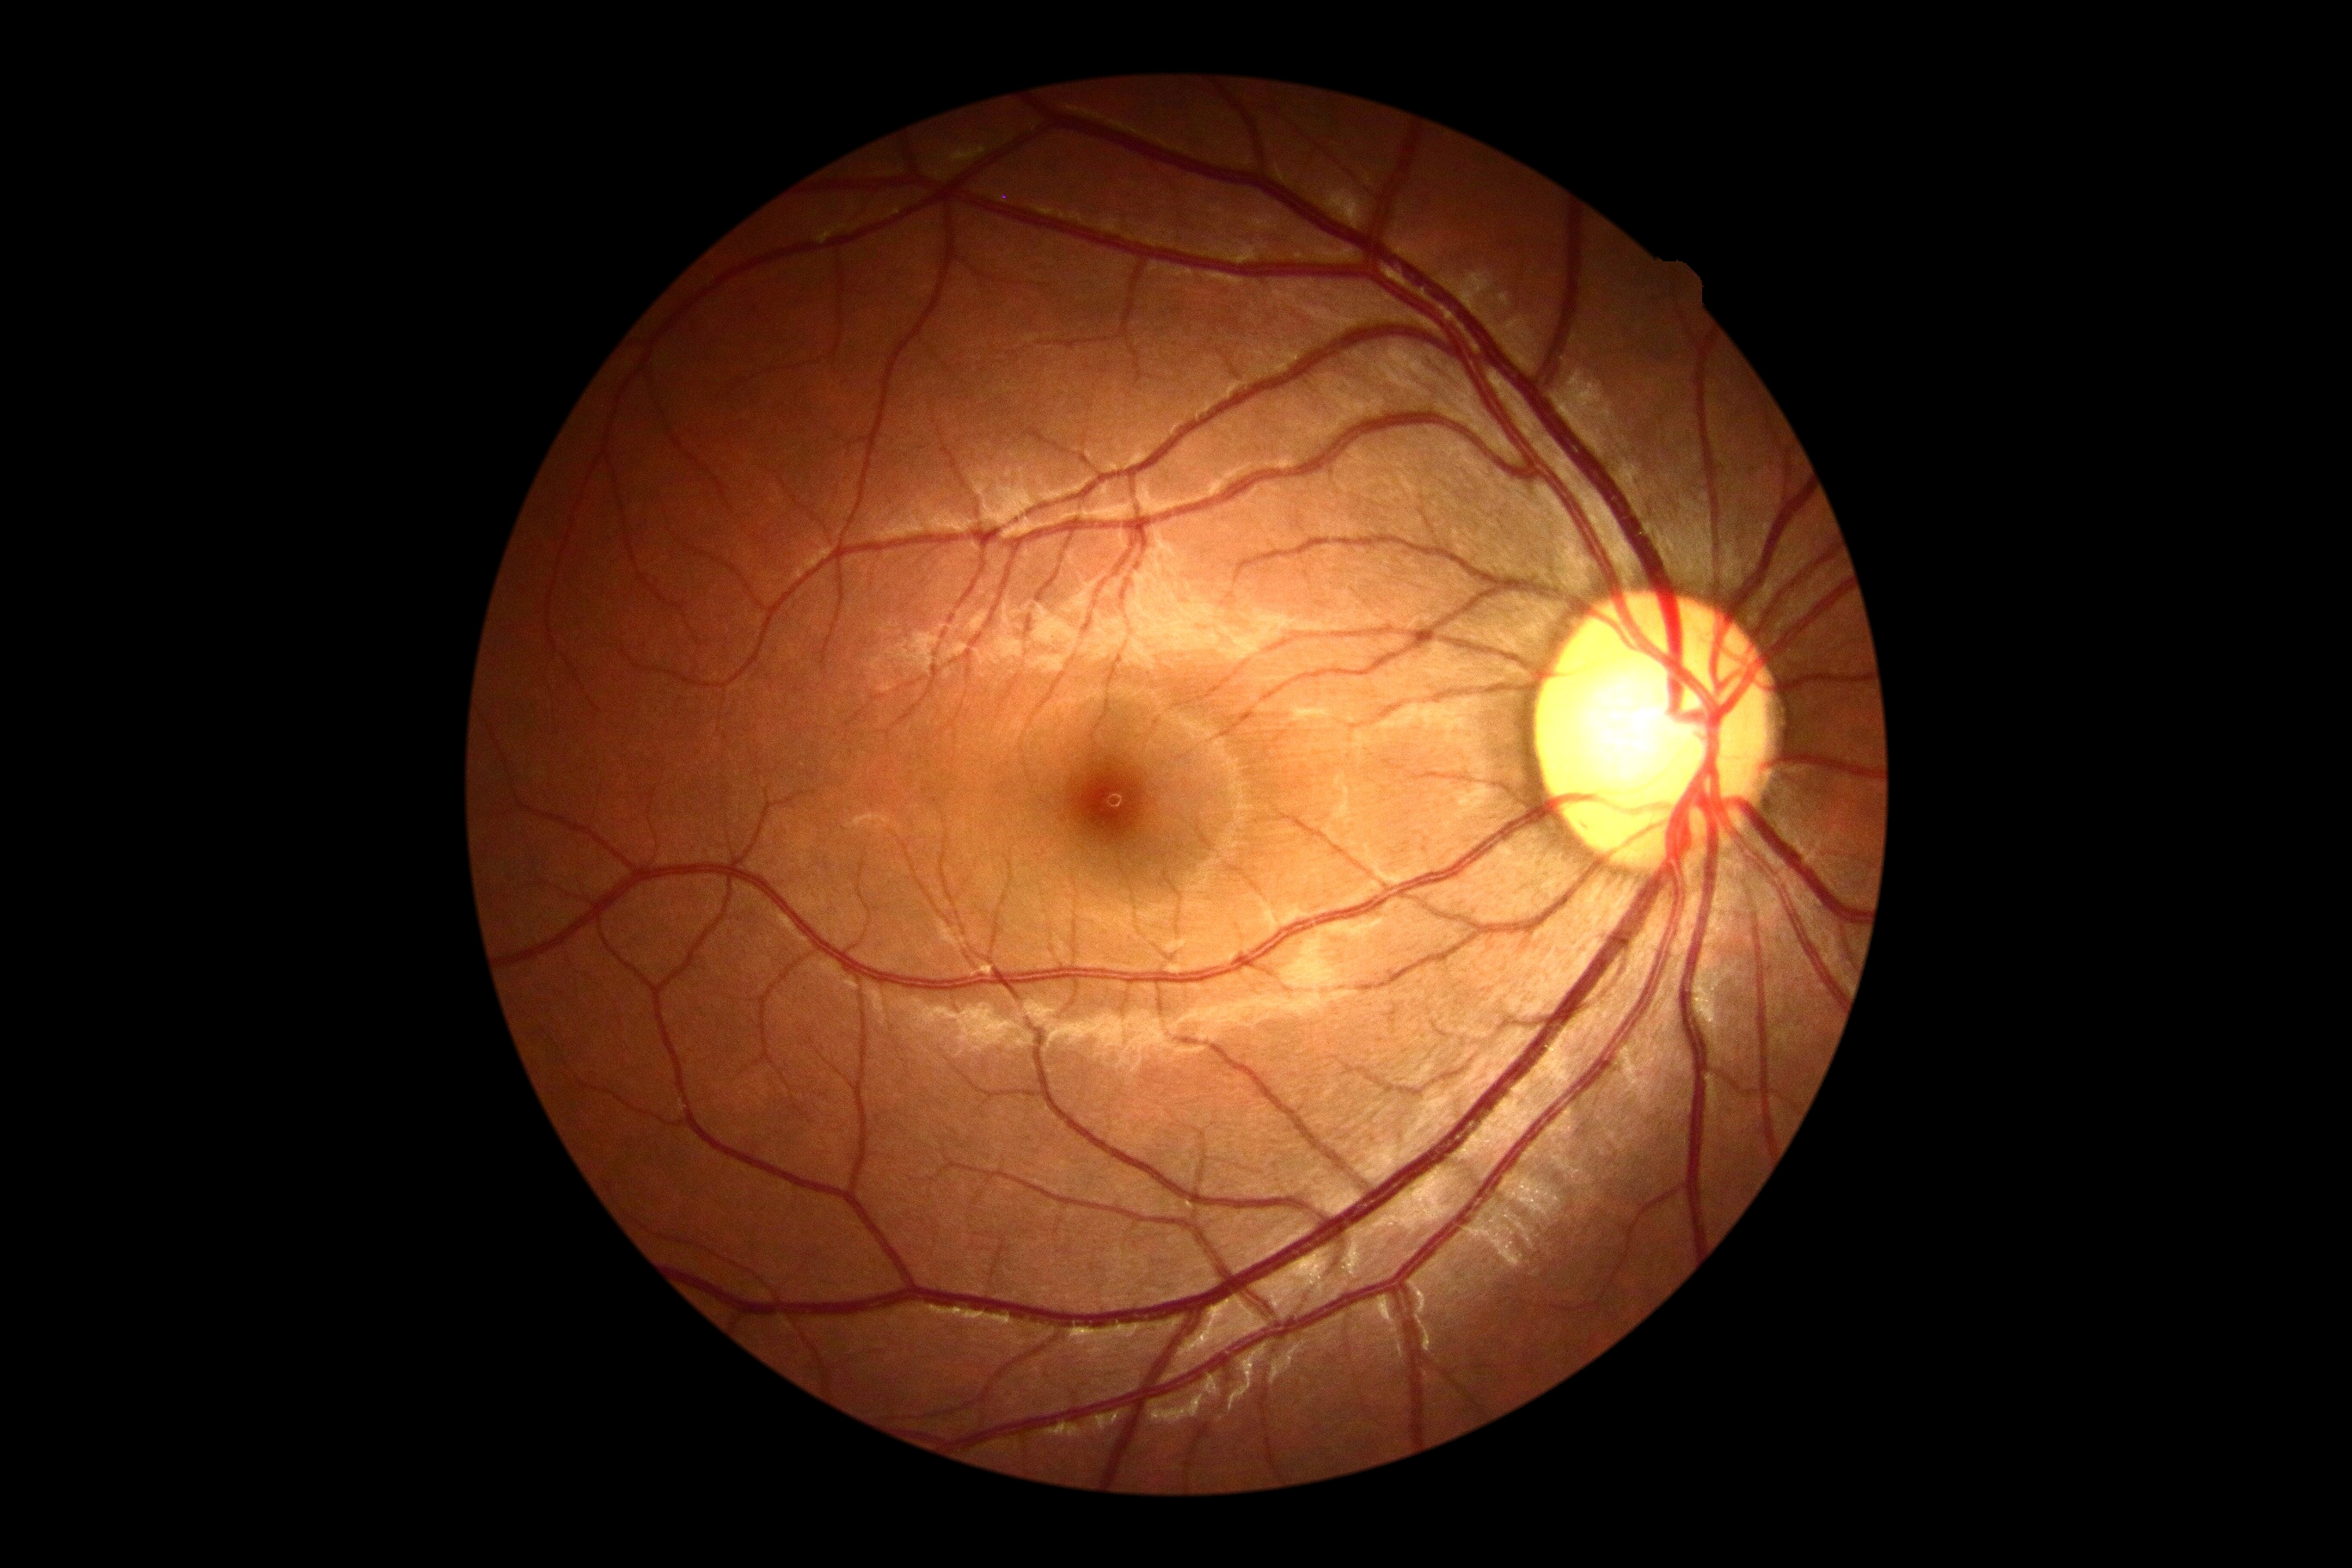

No DR findings.
Diabetic retinopathy grade is 0 (no apparent retinopathy).